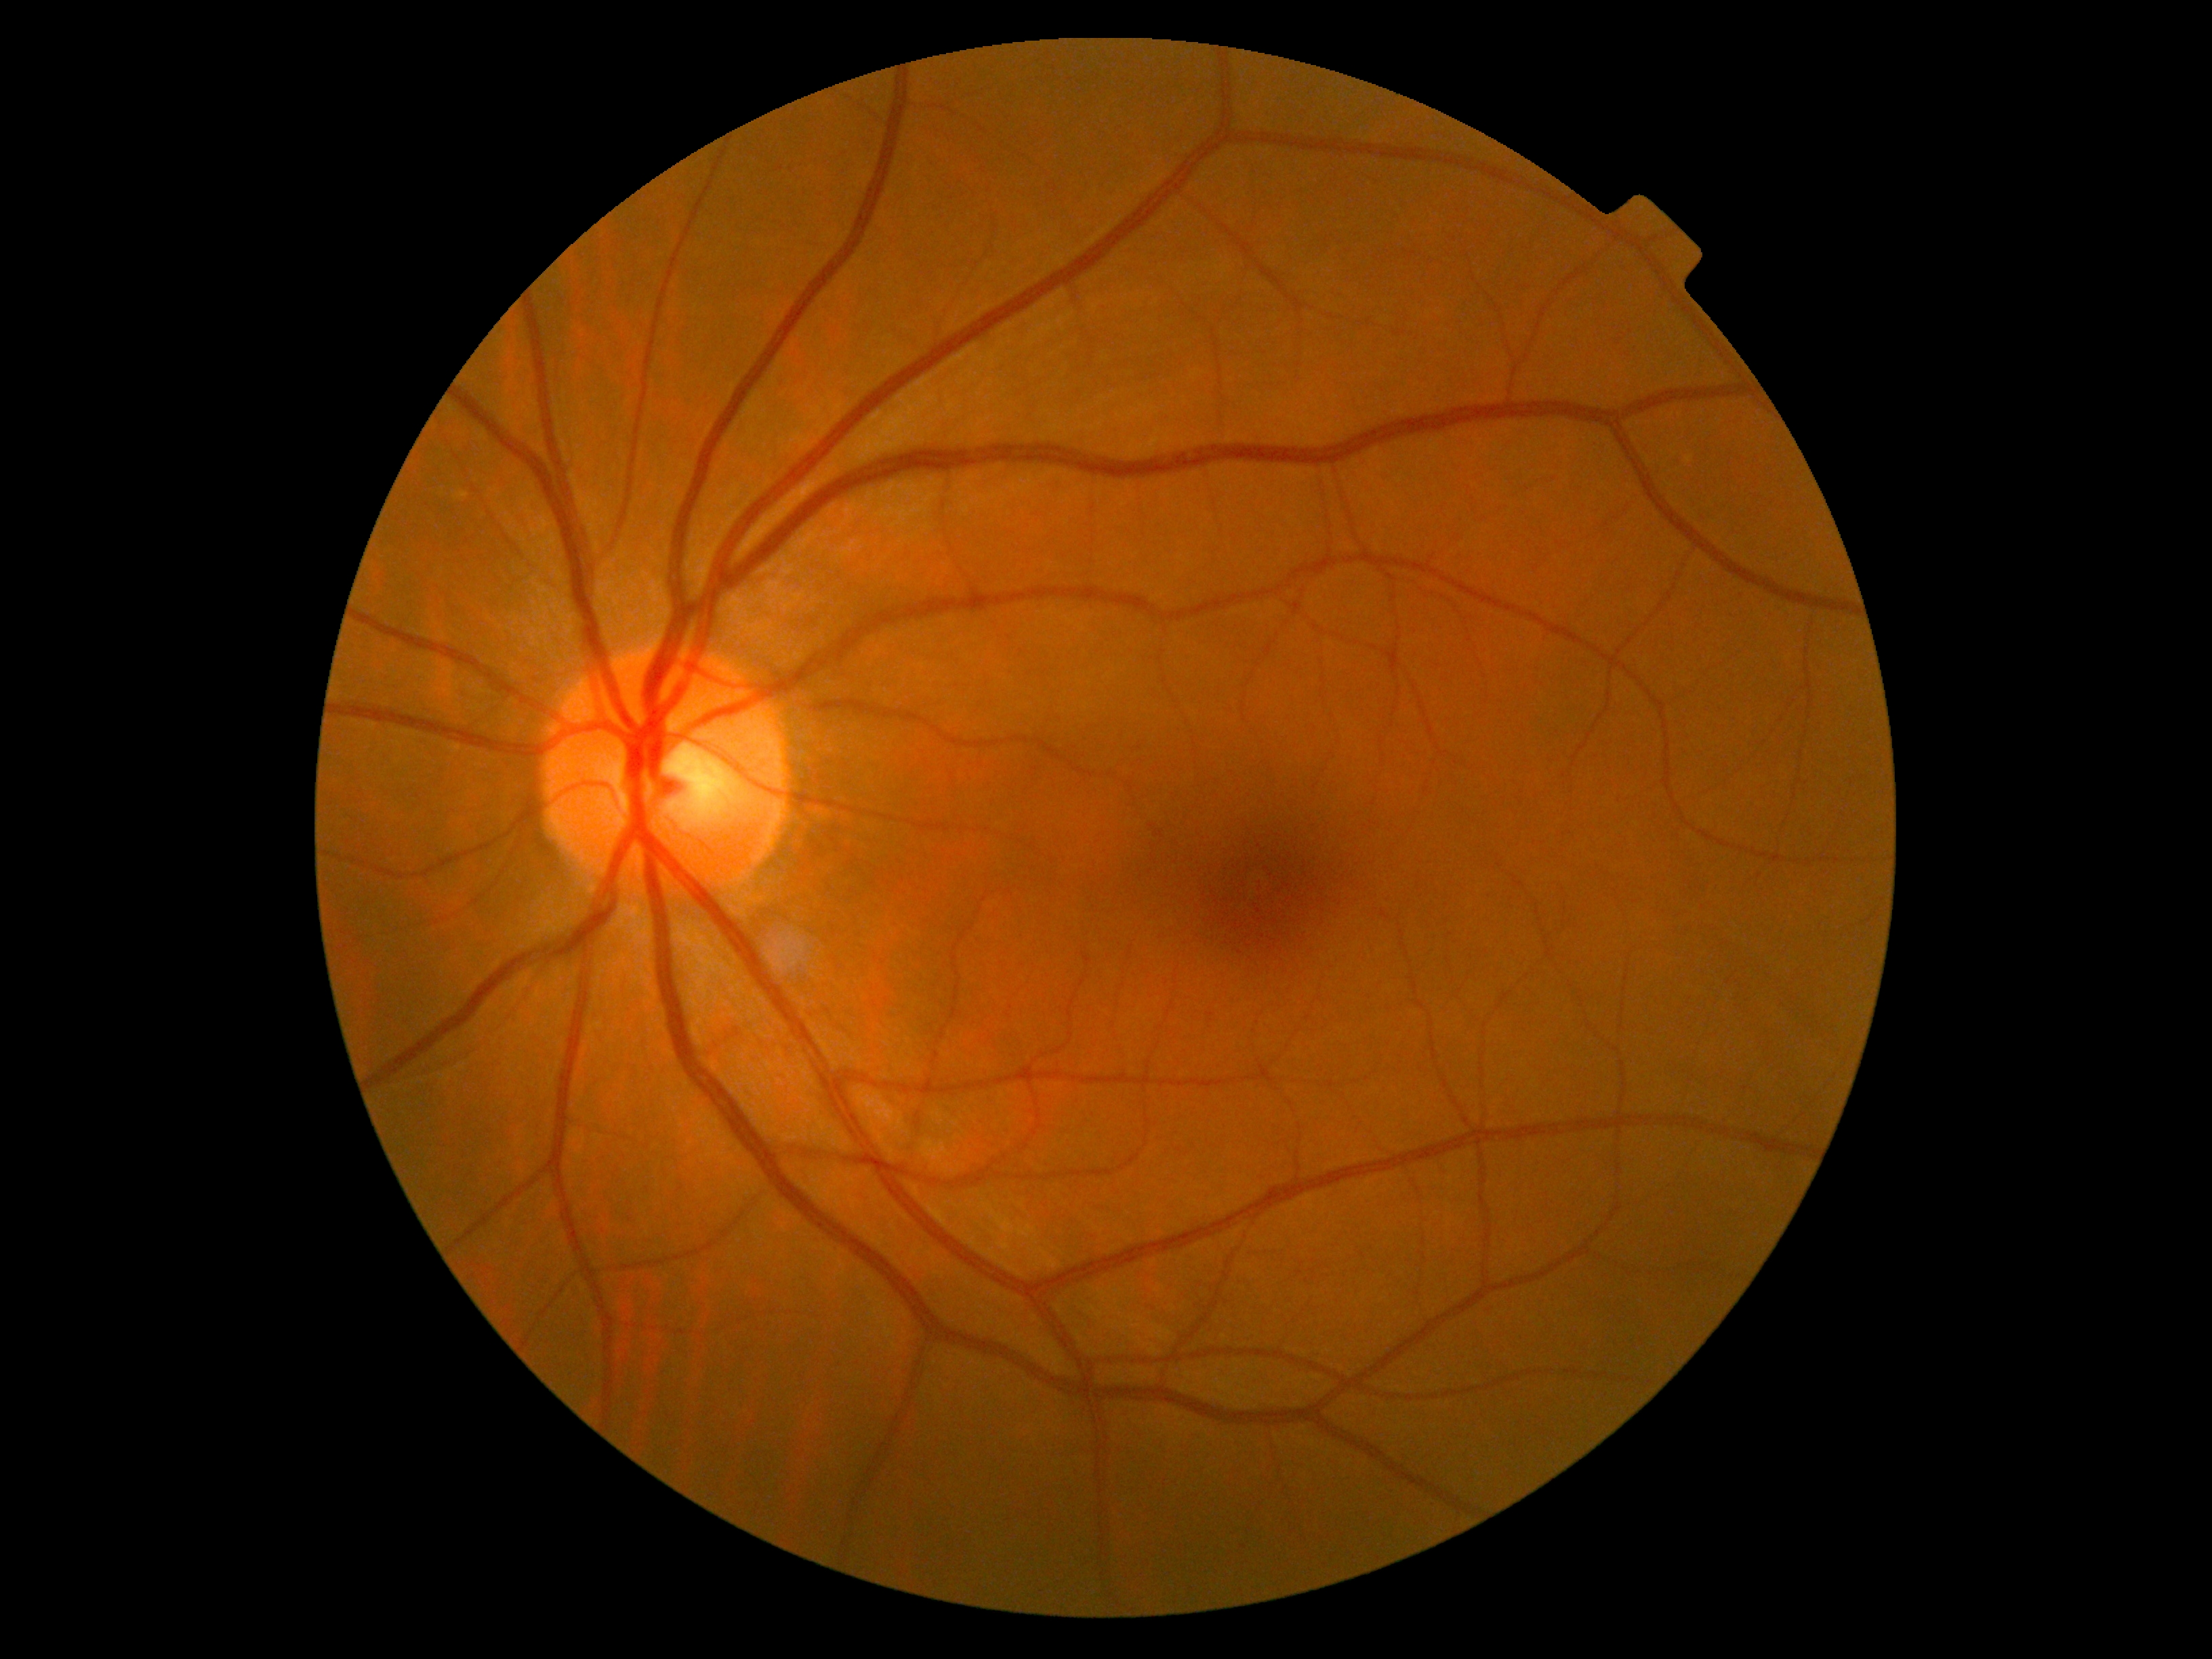 DR is grade 0 (no apparent retinopathy). No DR findings.